130° field of view (Clarity RetCam 3); infant wide-field fundus photograph
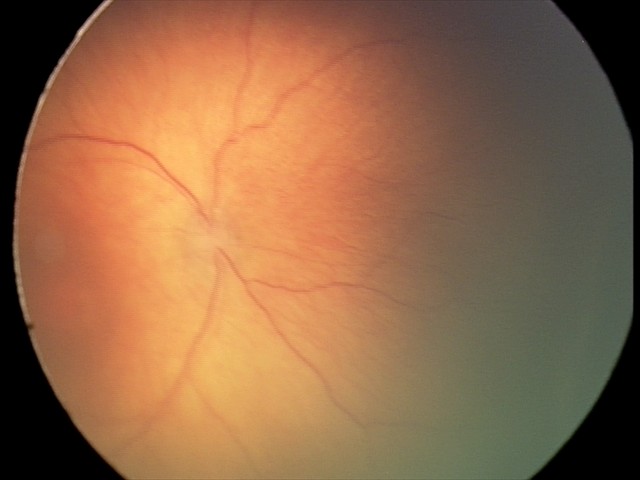
Examination diagnosed as ROP stage 2 — ridge with height and width at the demarcation line.